Retinal fundus photograph; 2089 x 1764 pixels
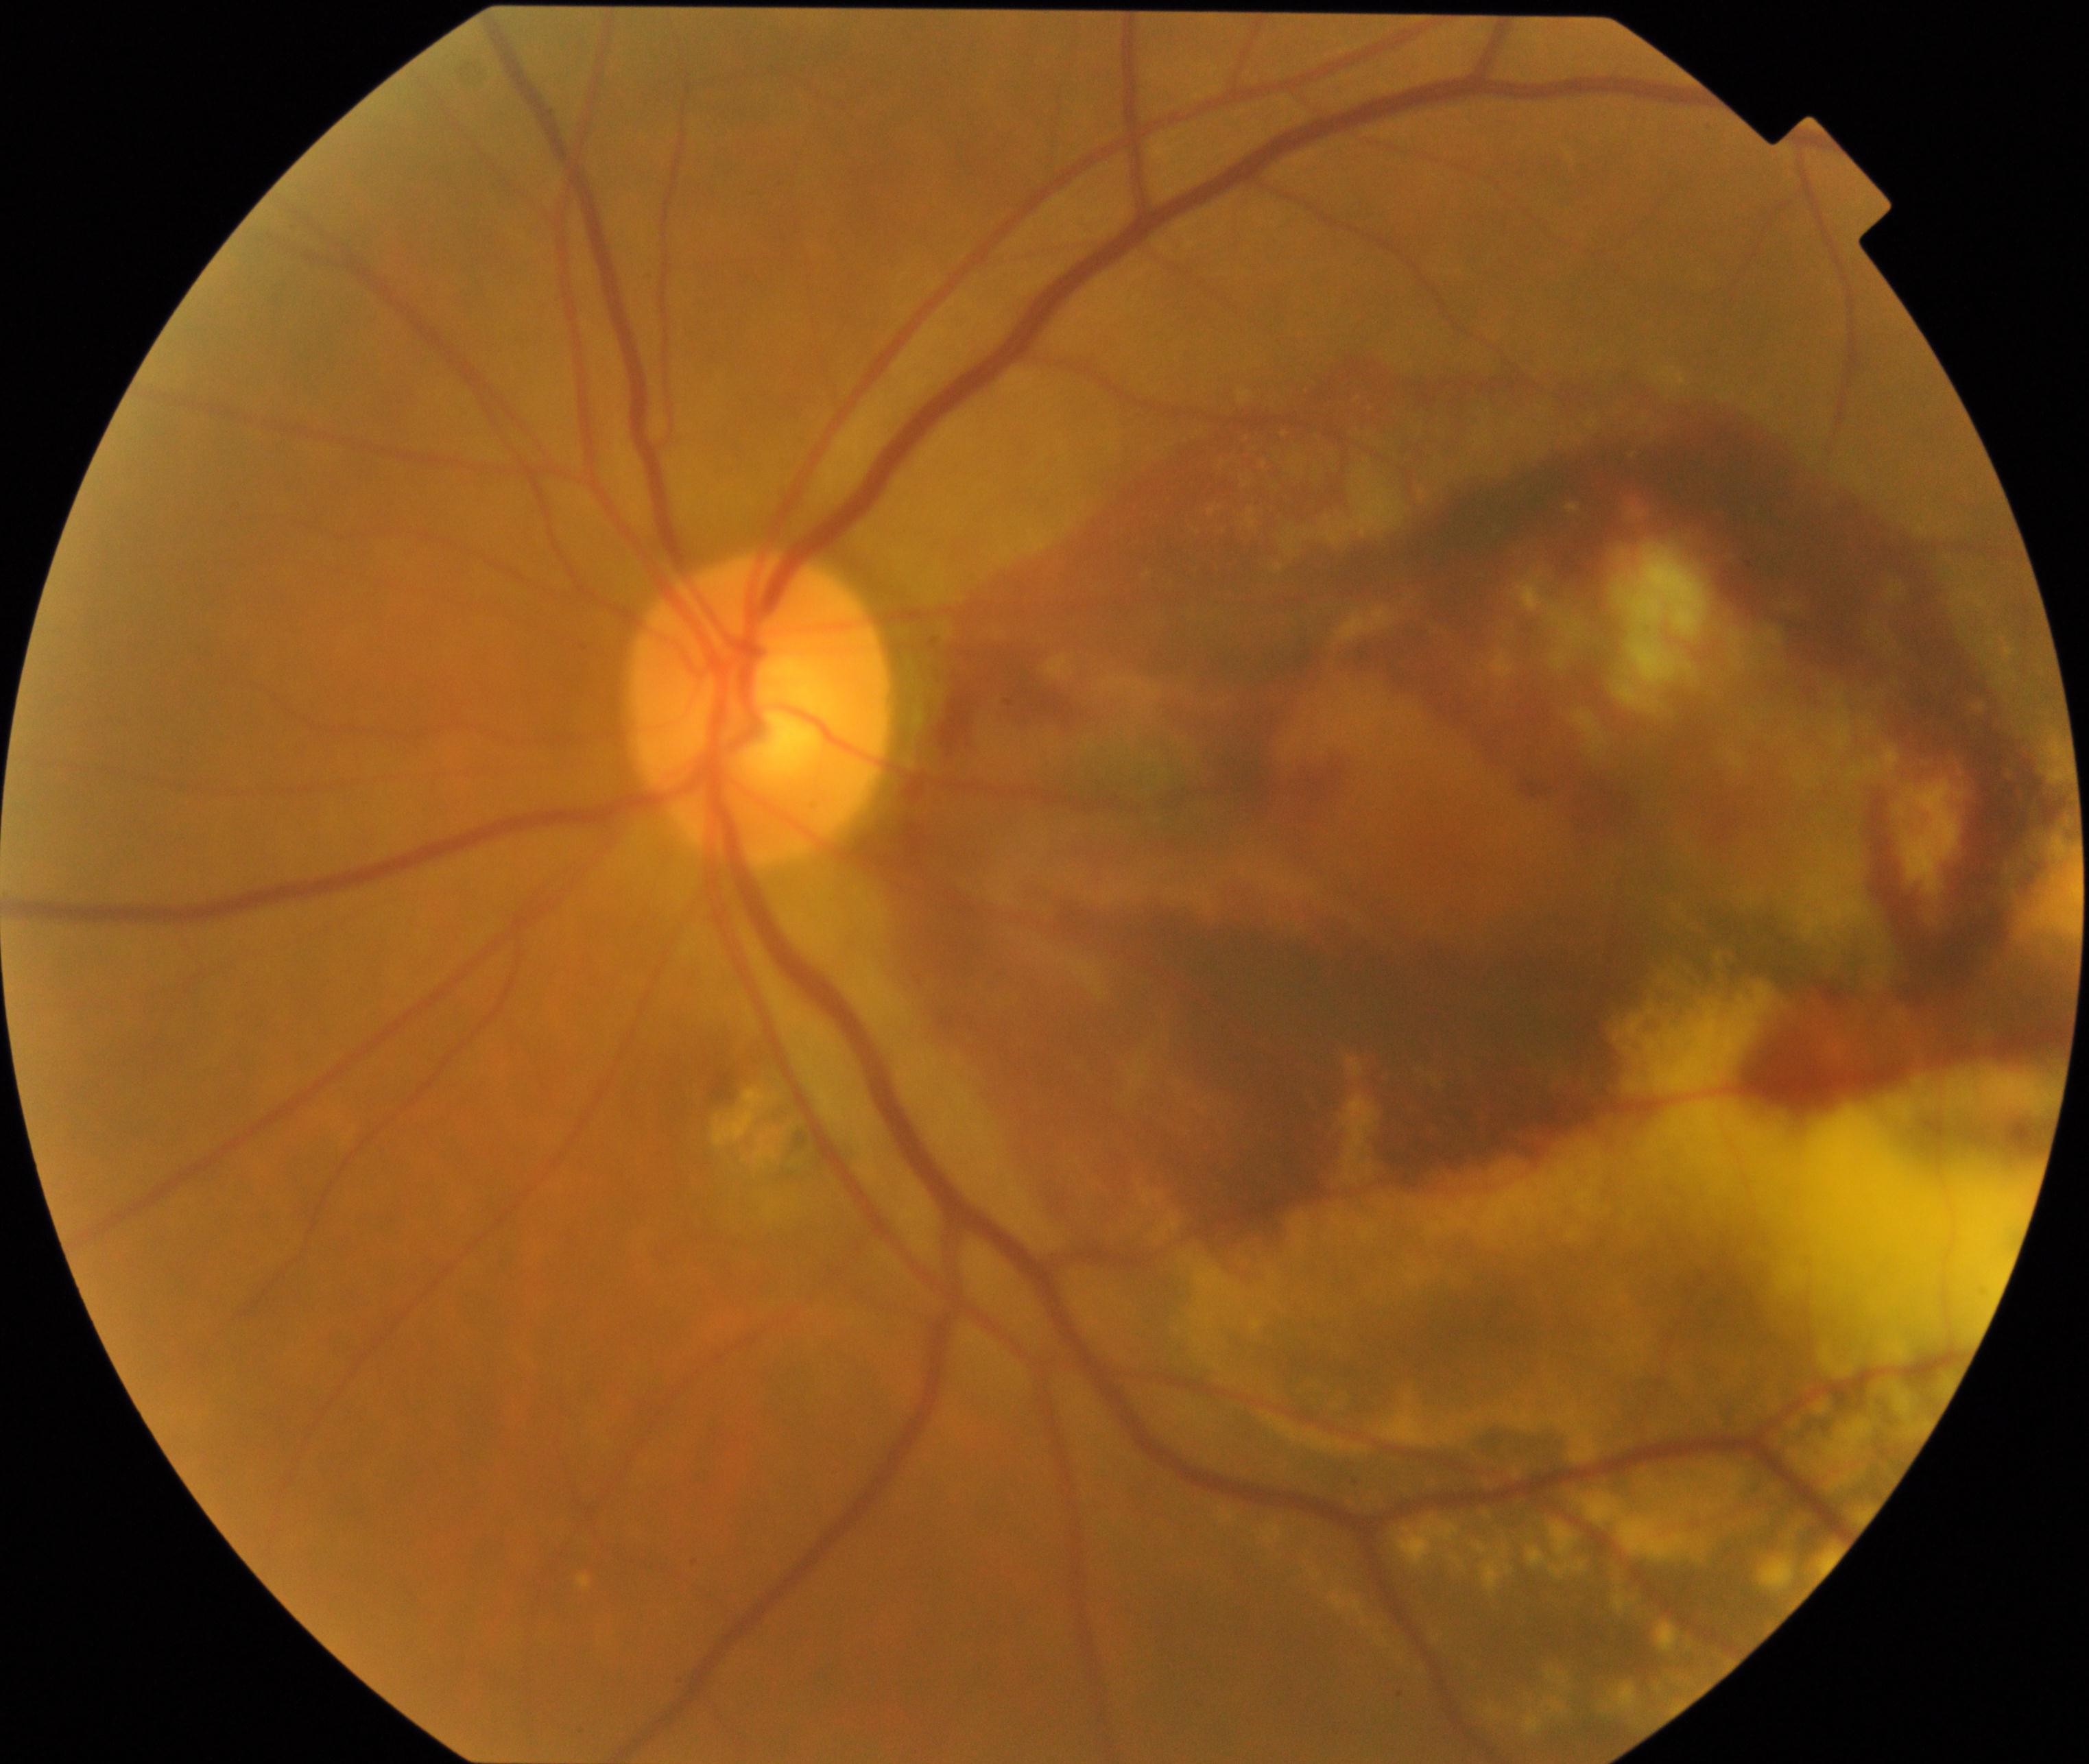 There is evidence of maculopathy.